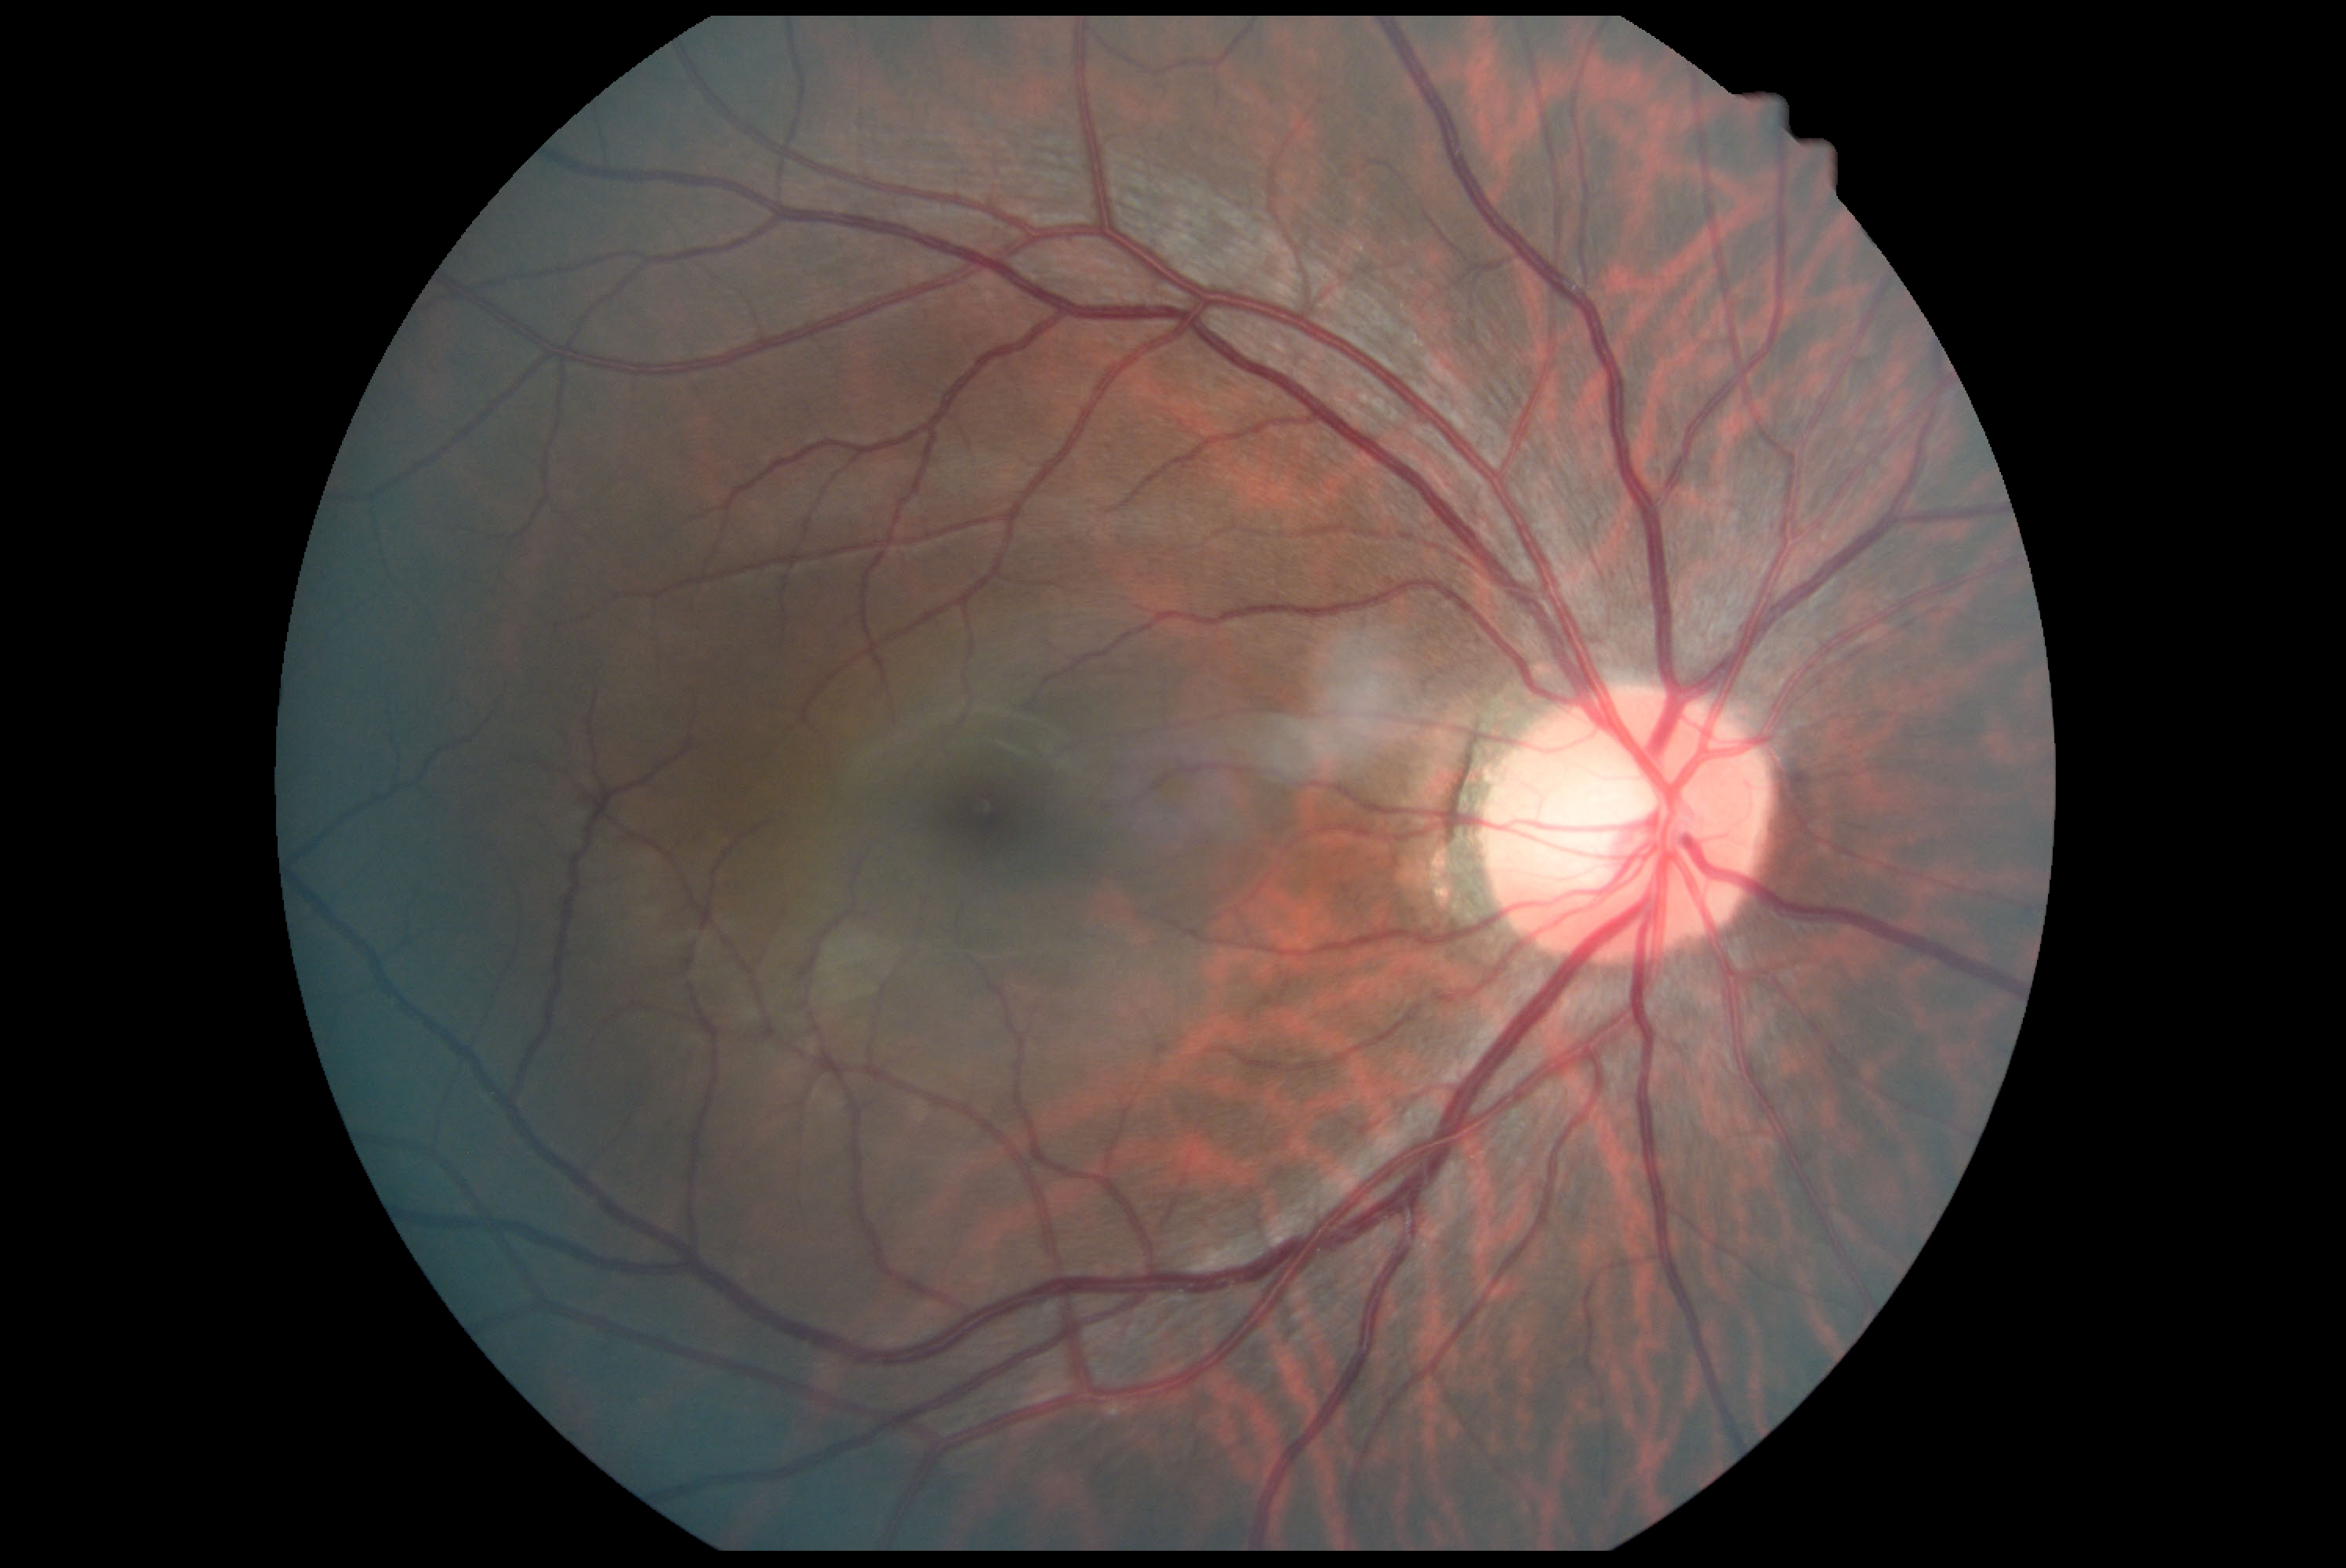 Diabetic retinopathy grade: 0/4.